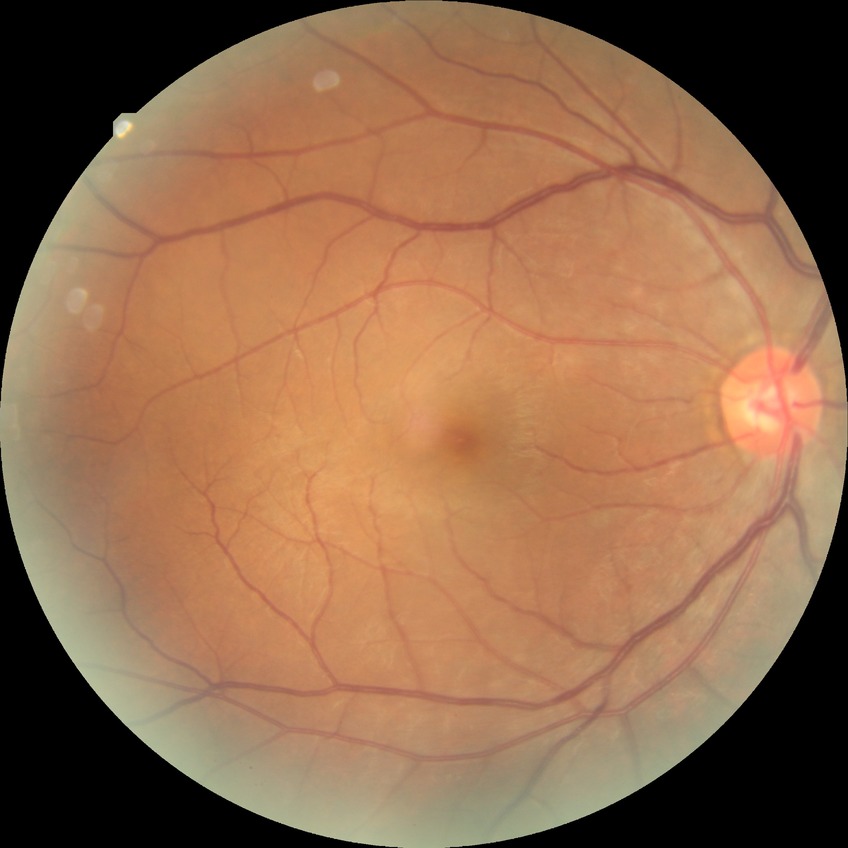

DR severity: NDR.